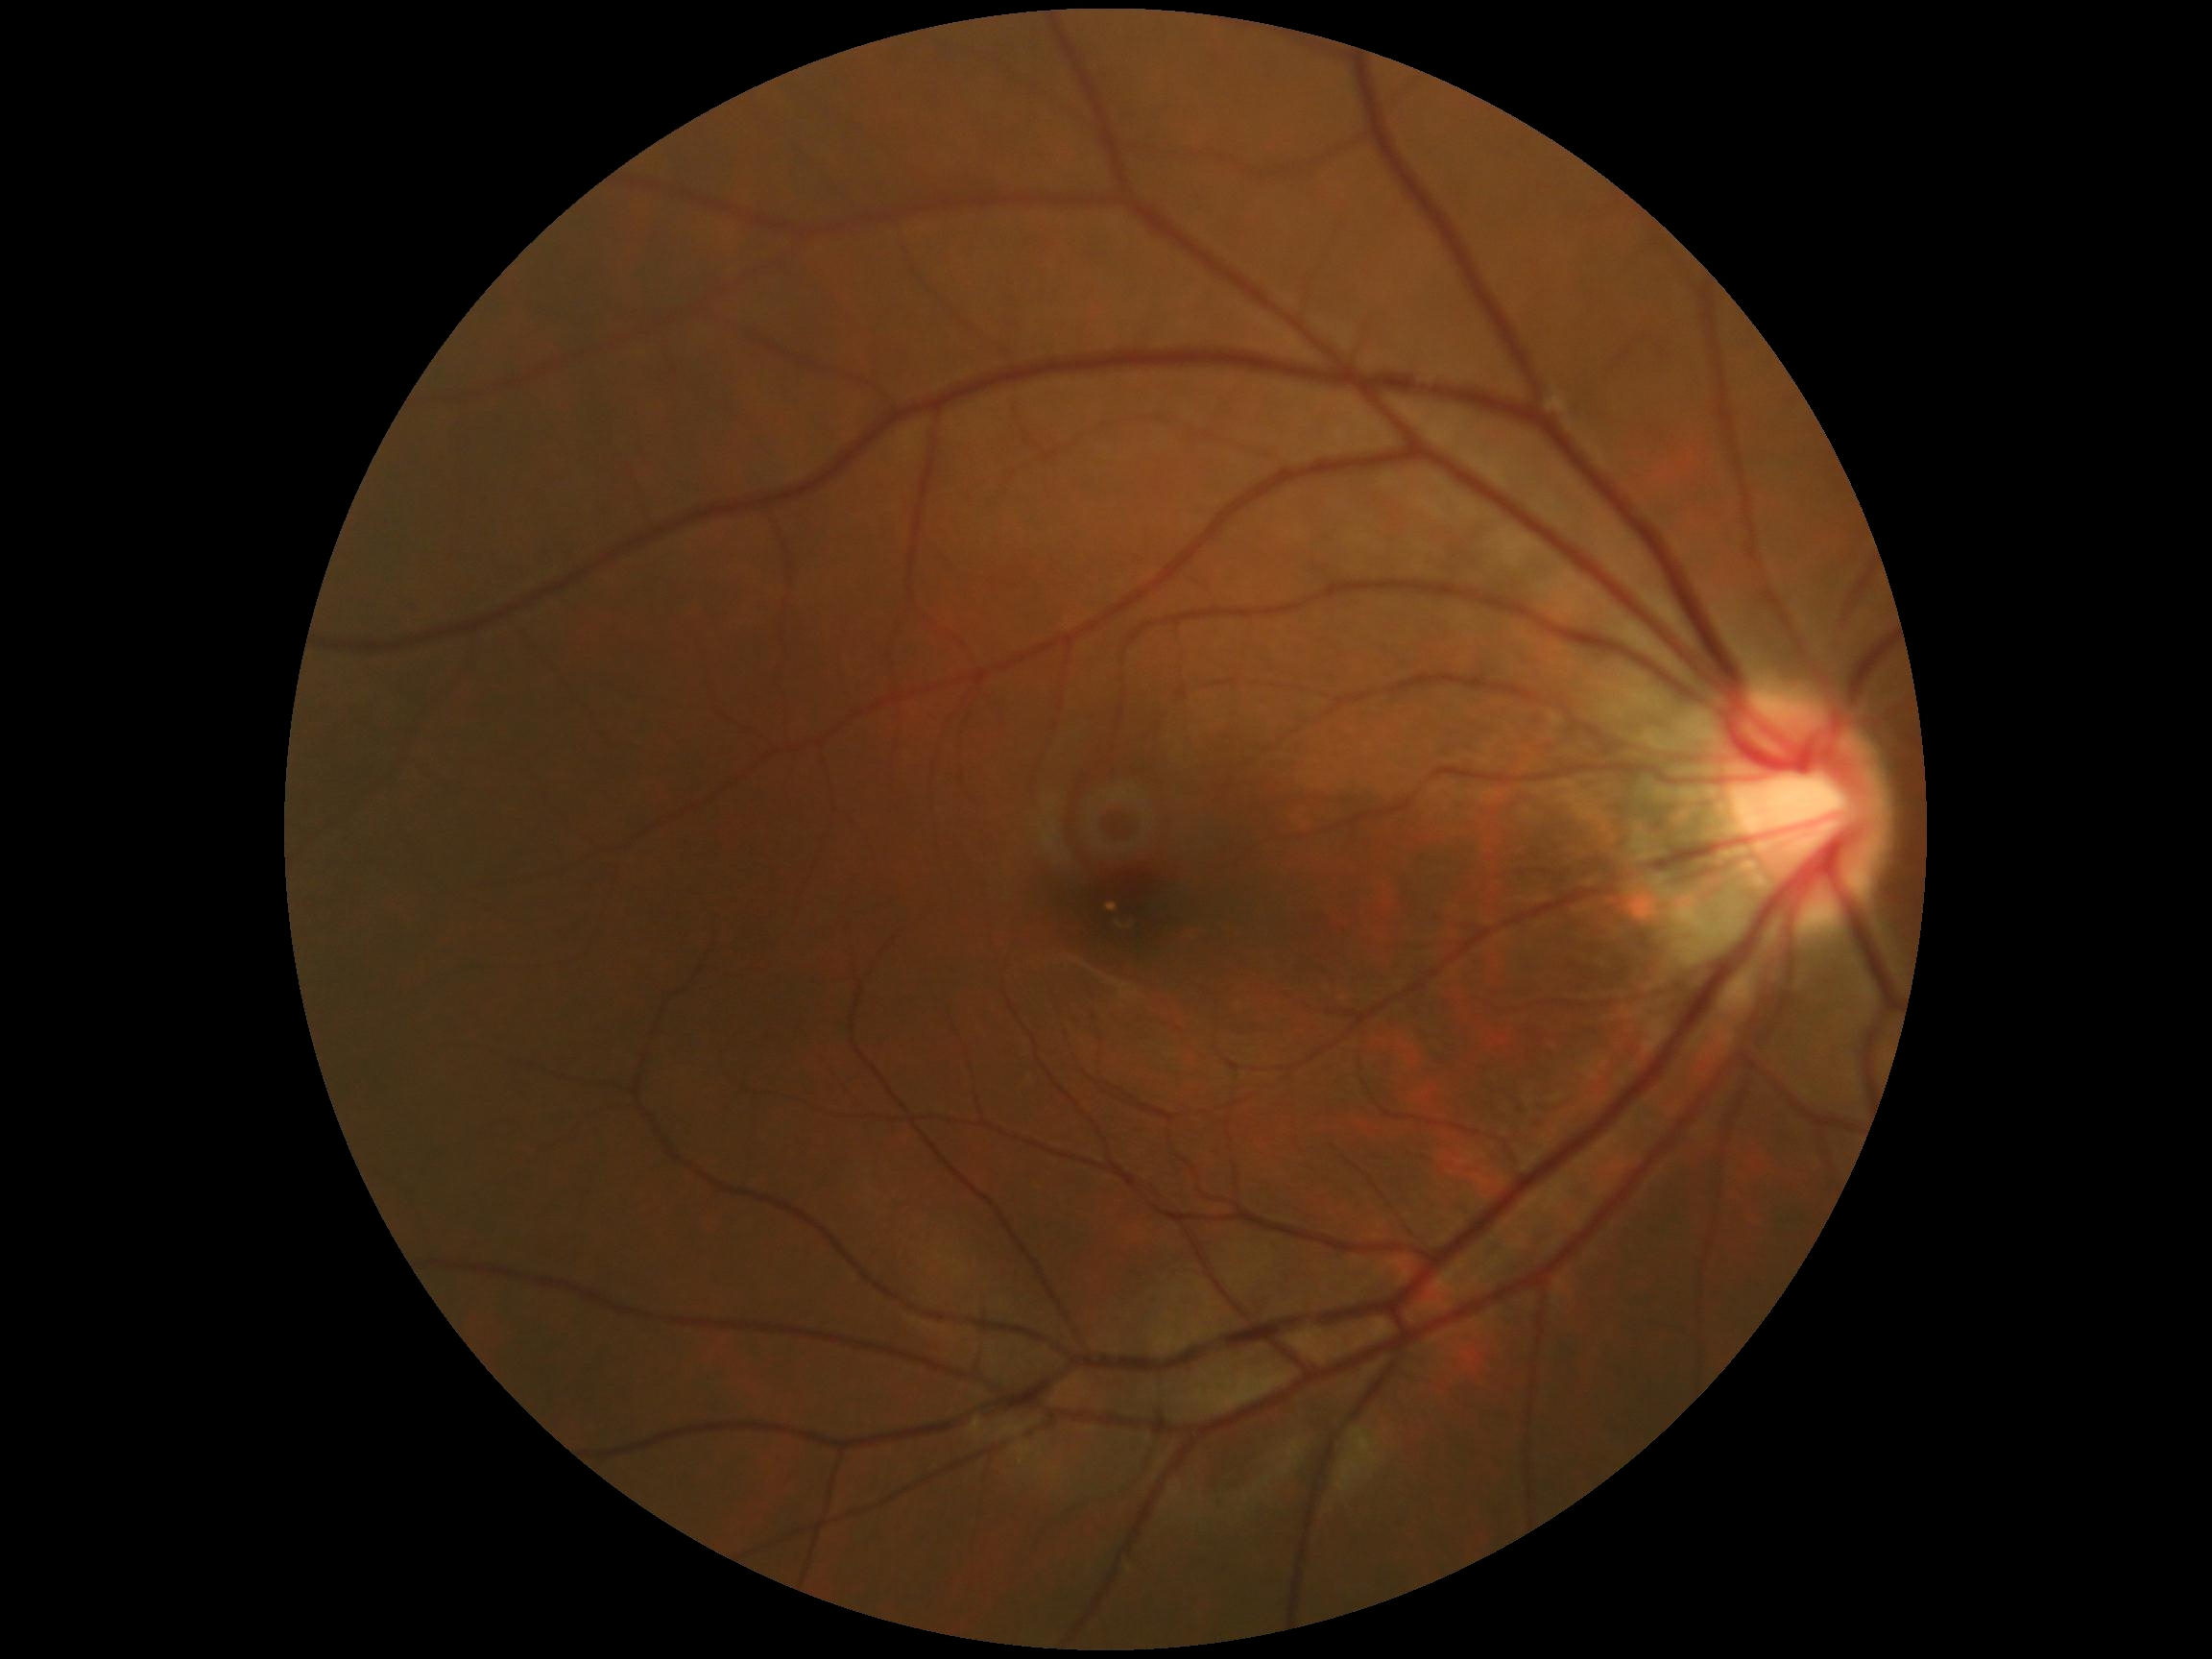 DR = no apparent retinopathy (grade 0); DR impression = no apparent DR.